Phoenix ICON wide-field infant fundus image.
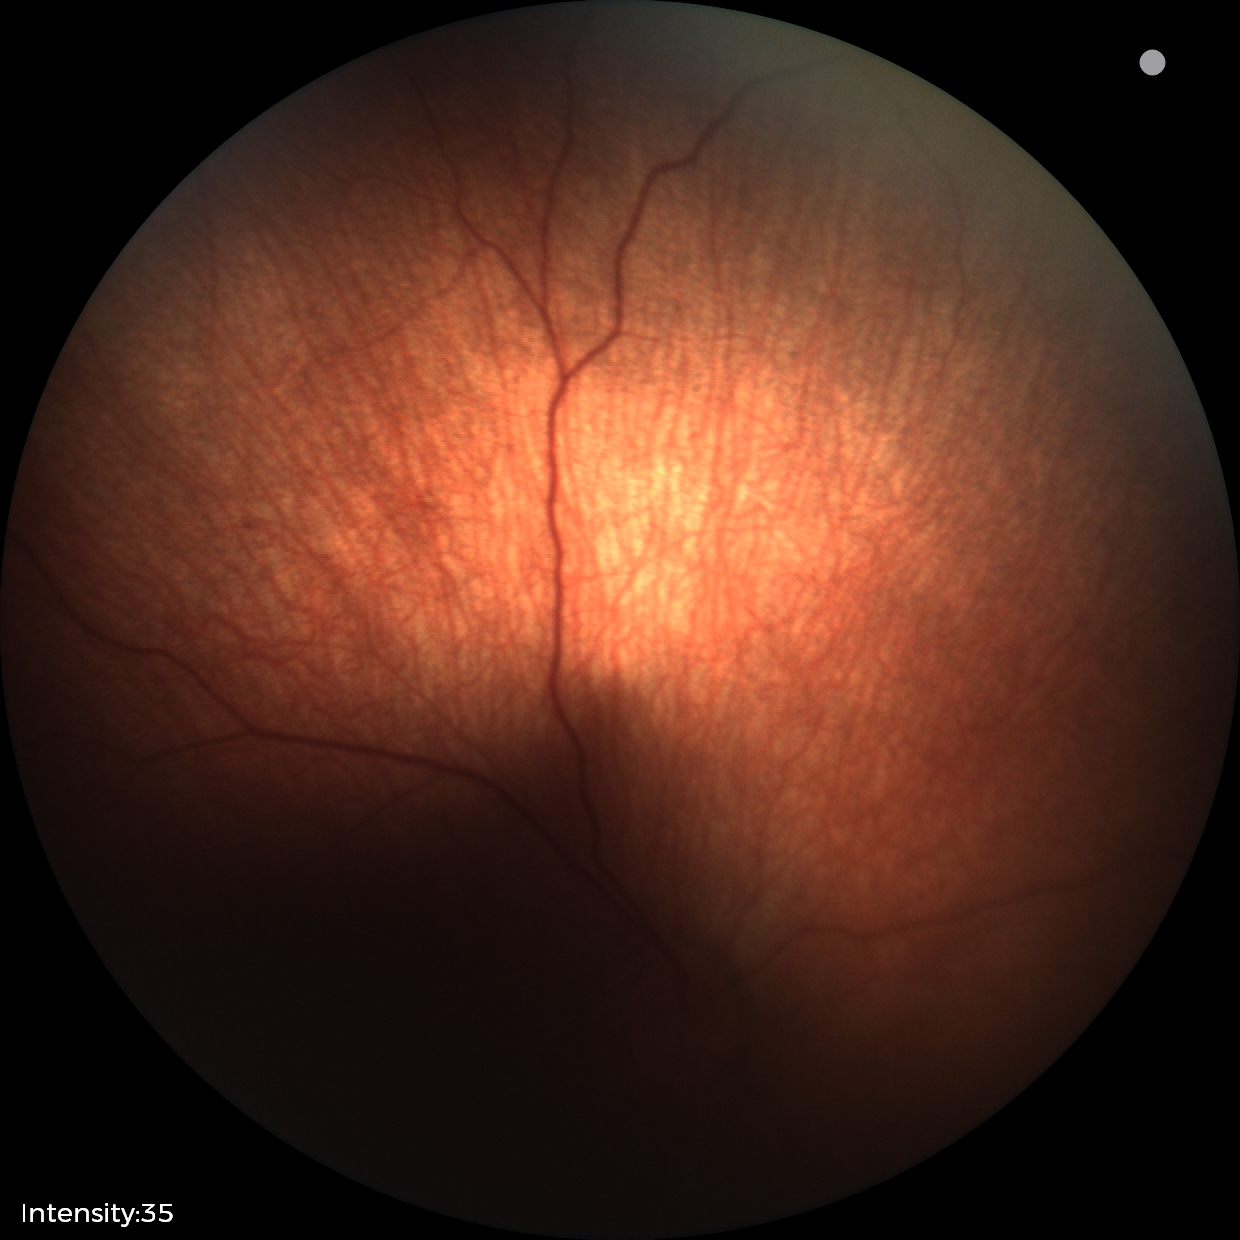

Normal screening examination.